Acquired with a NIDEK AFC-230 · modified Davis classification
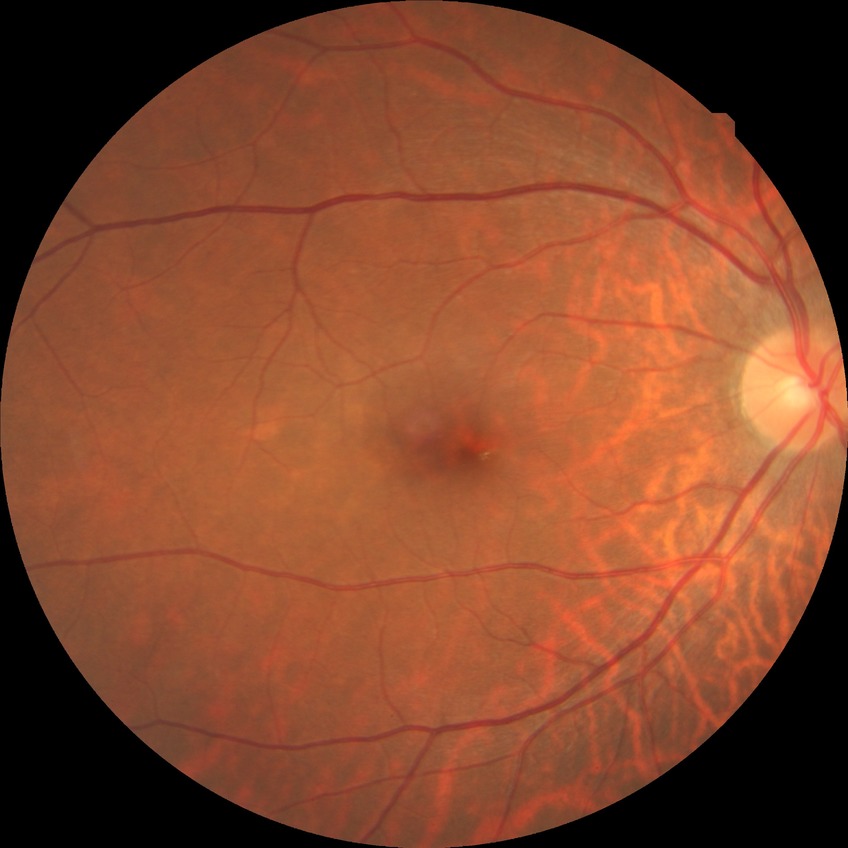

Retinopathy grade: no diabetic retinopathy.